Sex: M. Axial length (AL) 27.87 mm. 59-year-old patient. Image size 2212x1661. Topcon TRC-NW400. Color fundus image. Non-mydriatic. 30-degree field of view. Optic disc at the center of the field. Intraocular pressure (IOP) 16 mmHg (applanation tonometry). Central corneal thickness 570 µm: 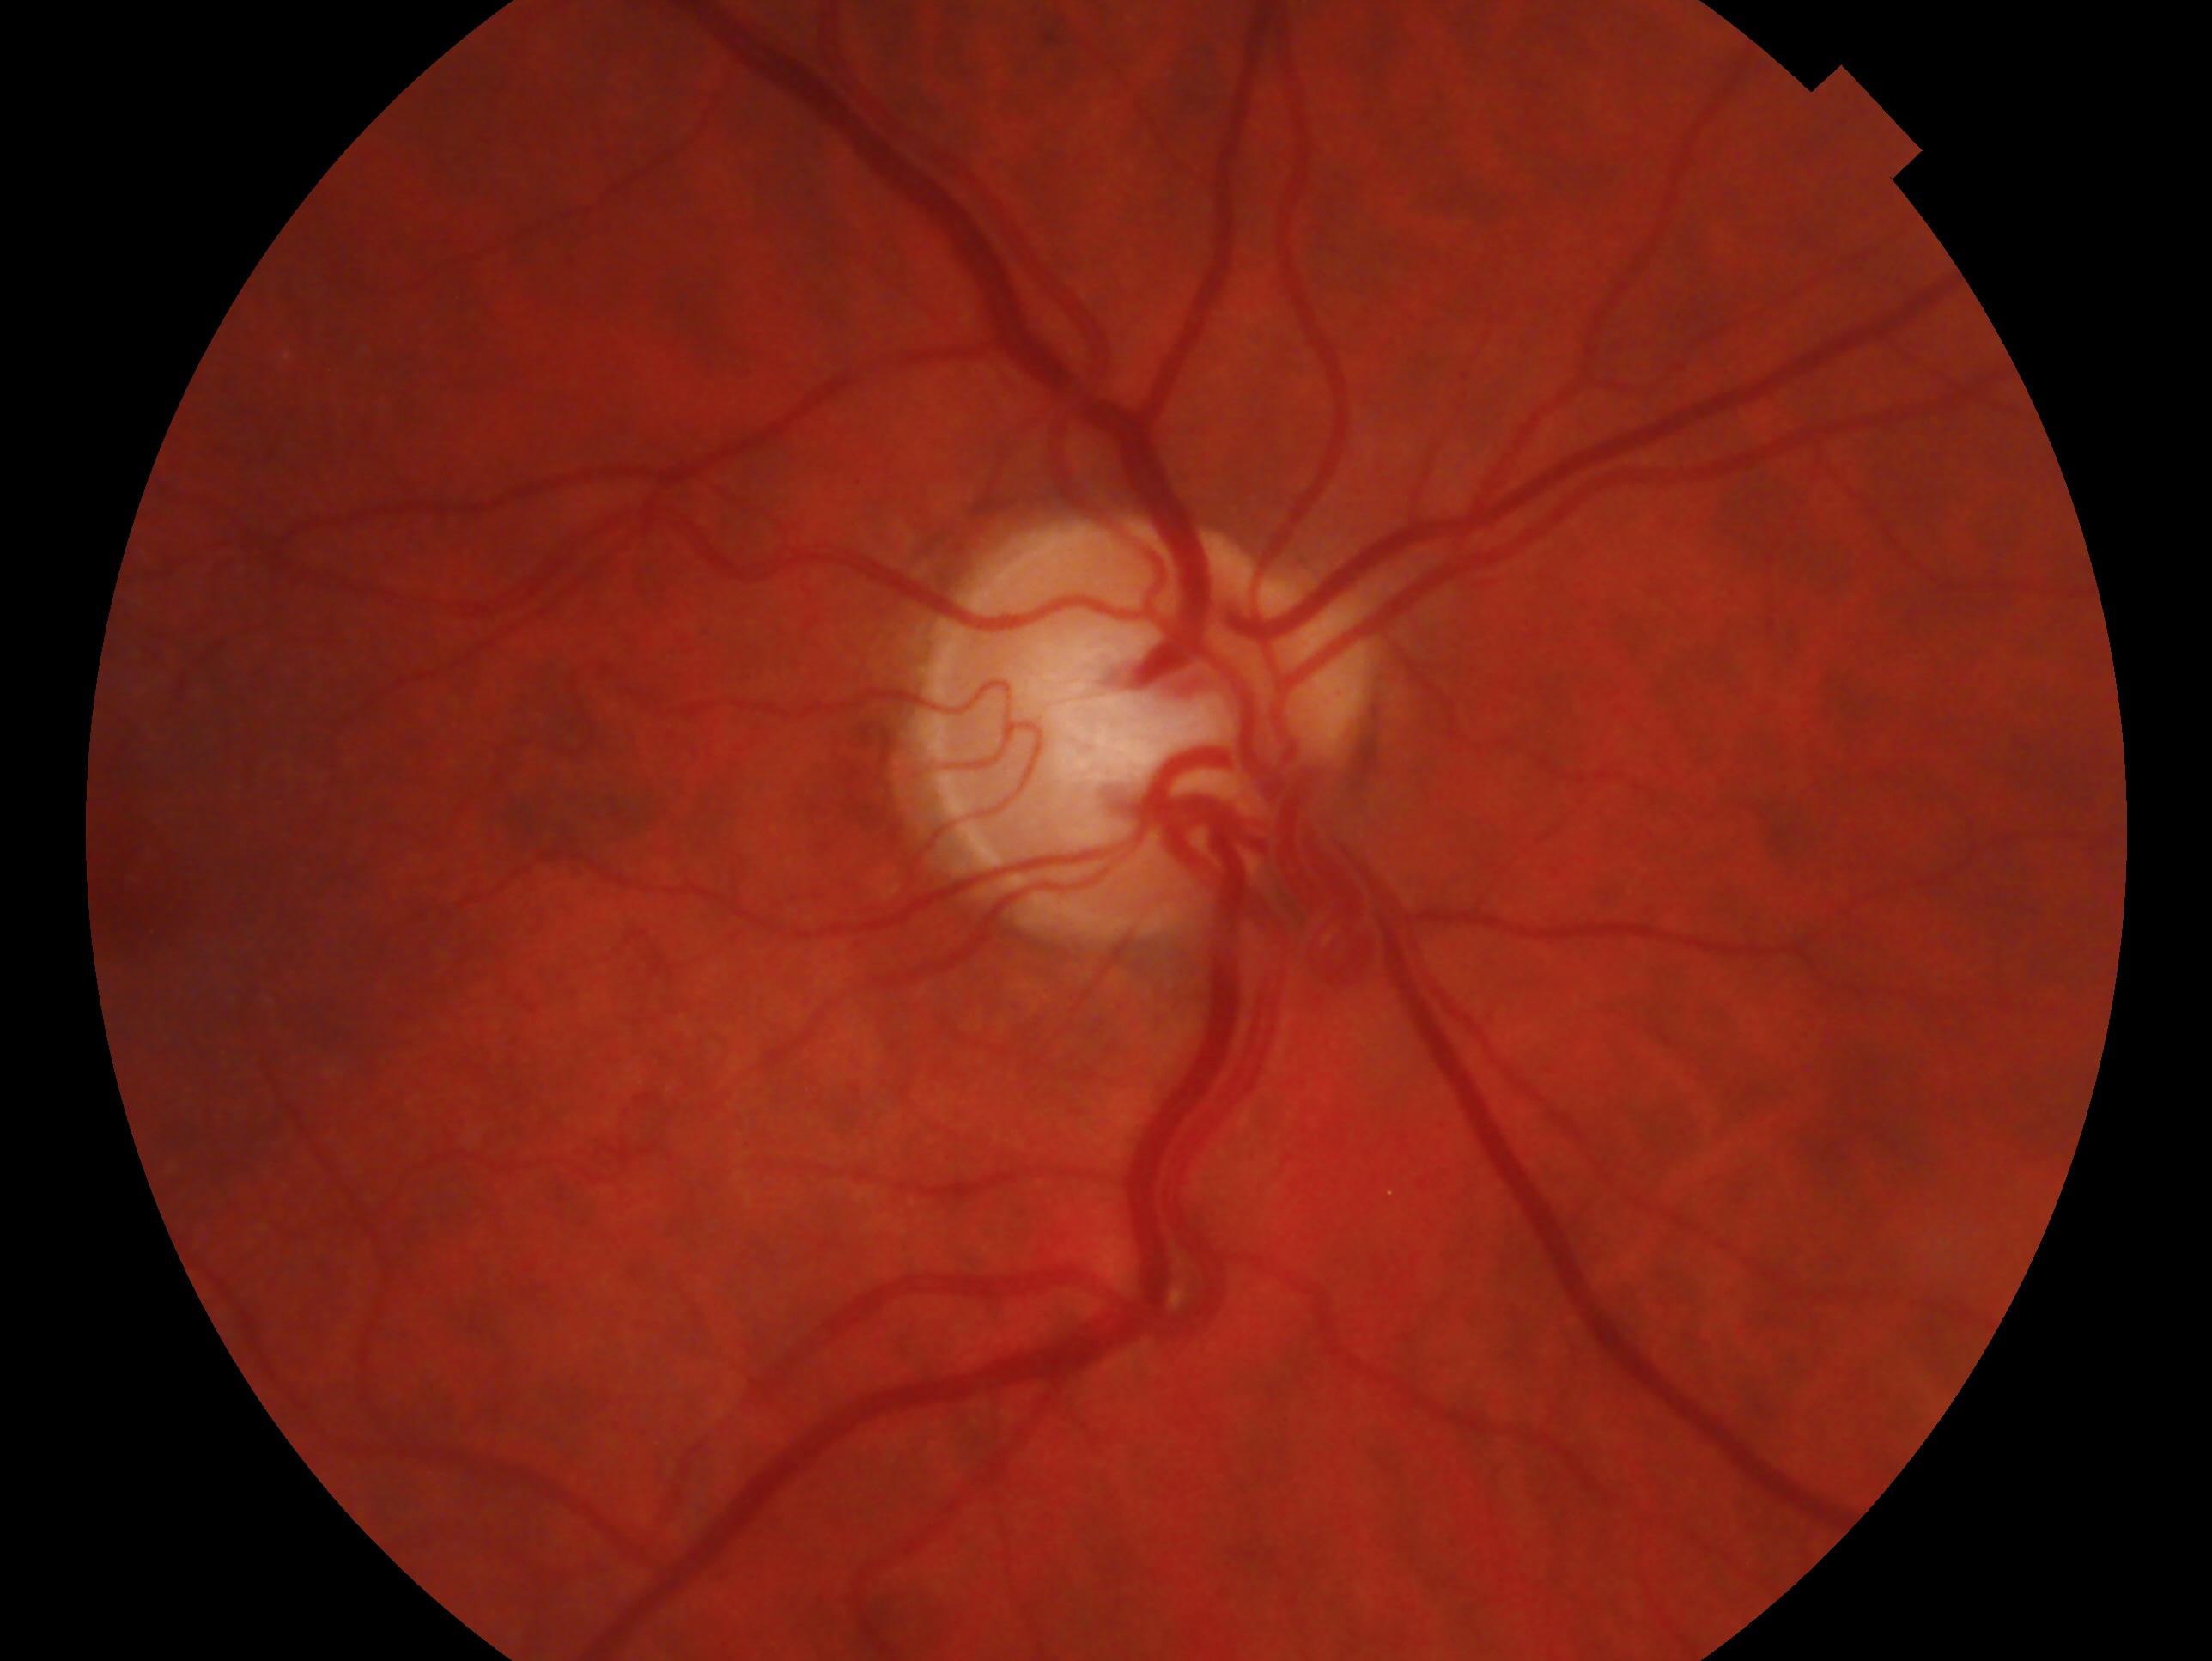
diagnosis: glaucoma suspect
laterality: right